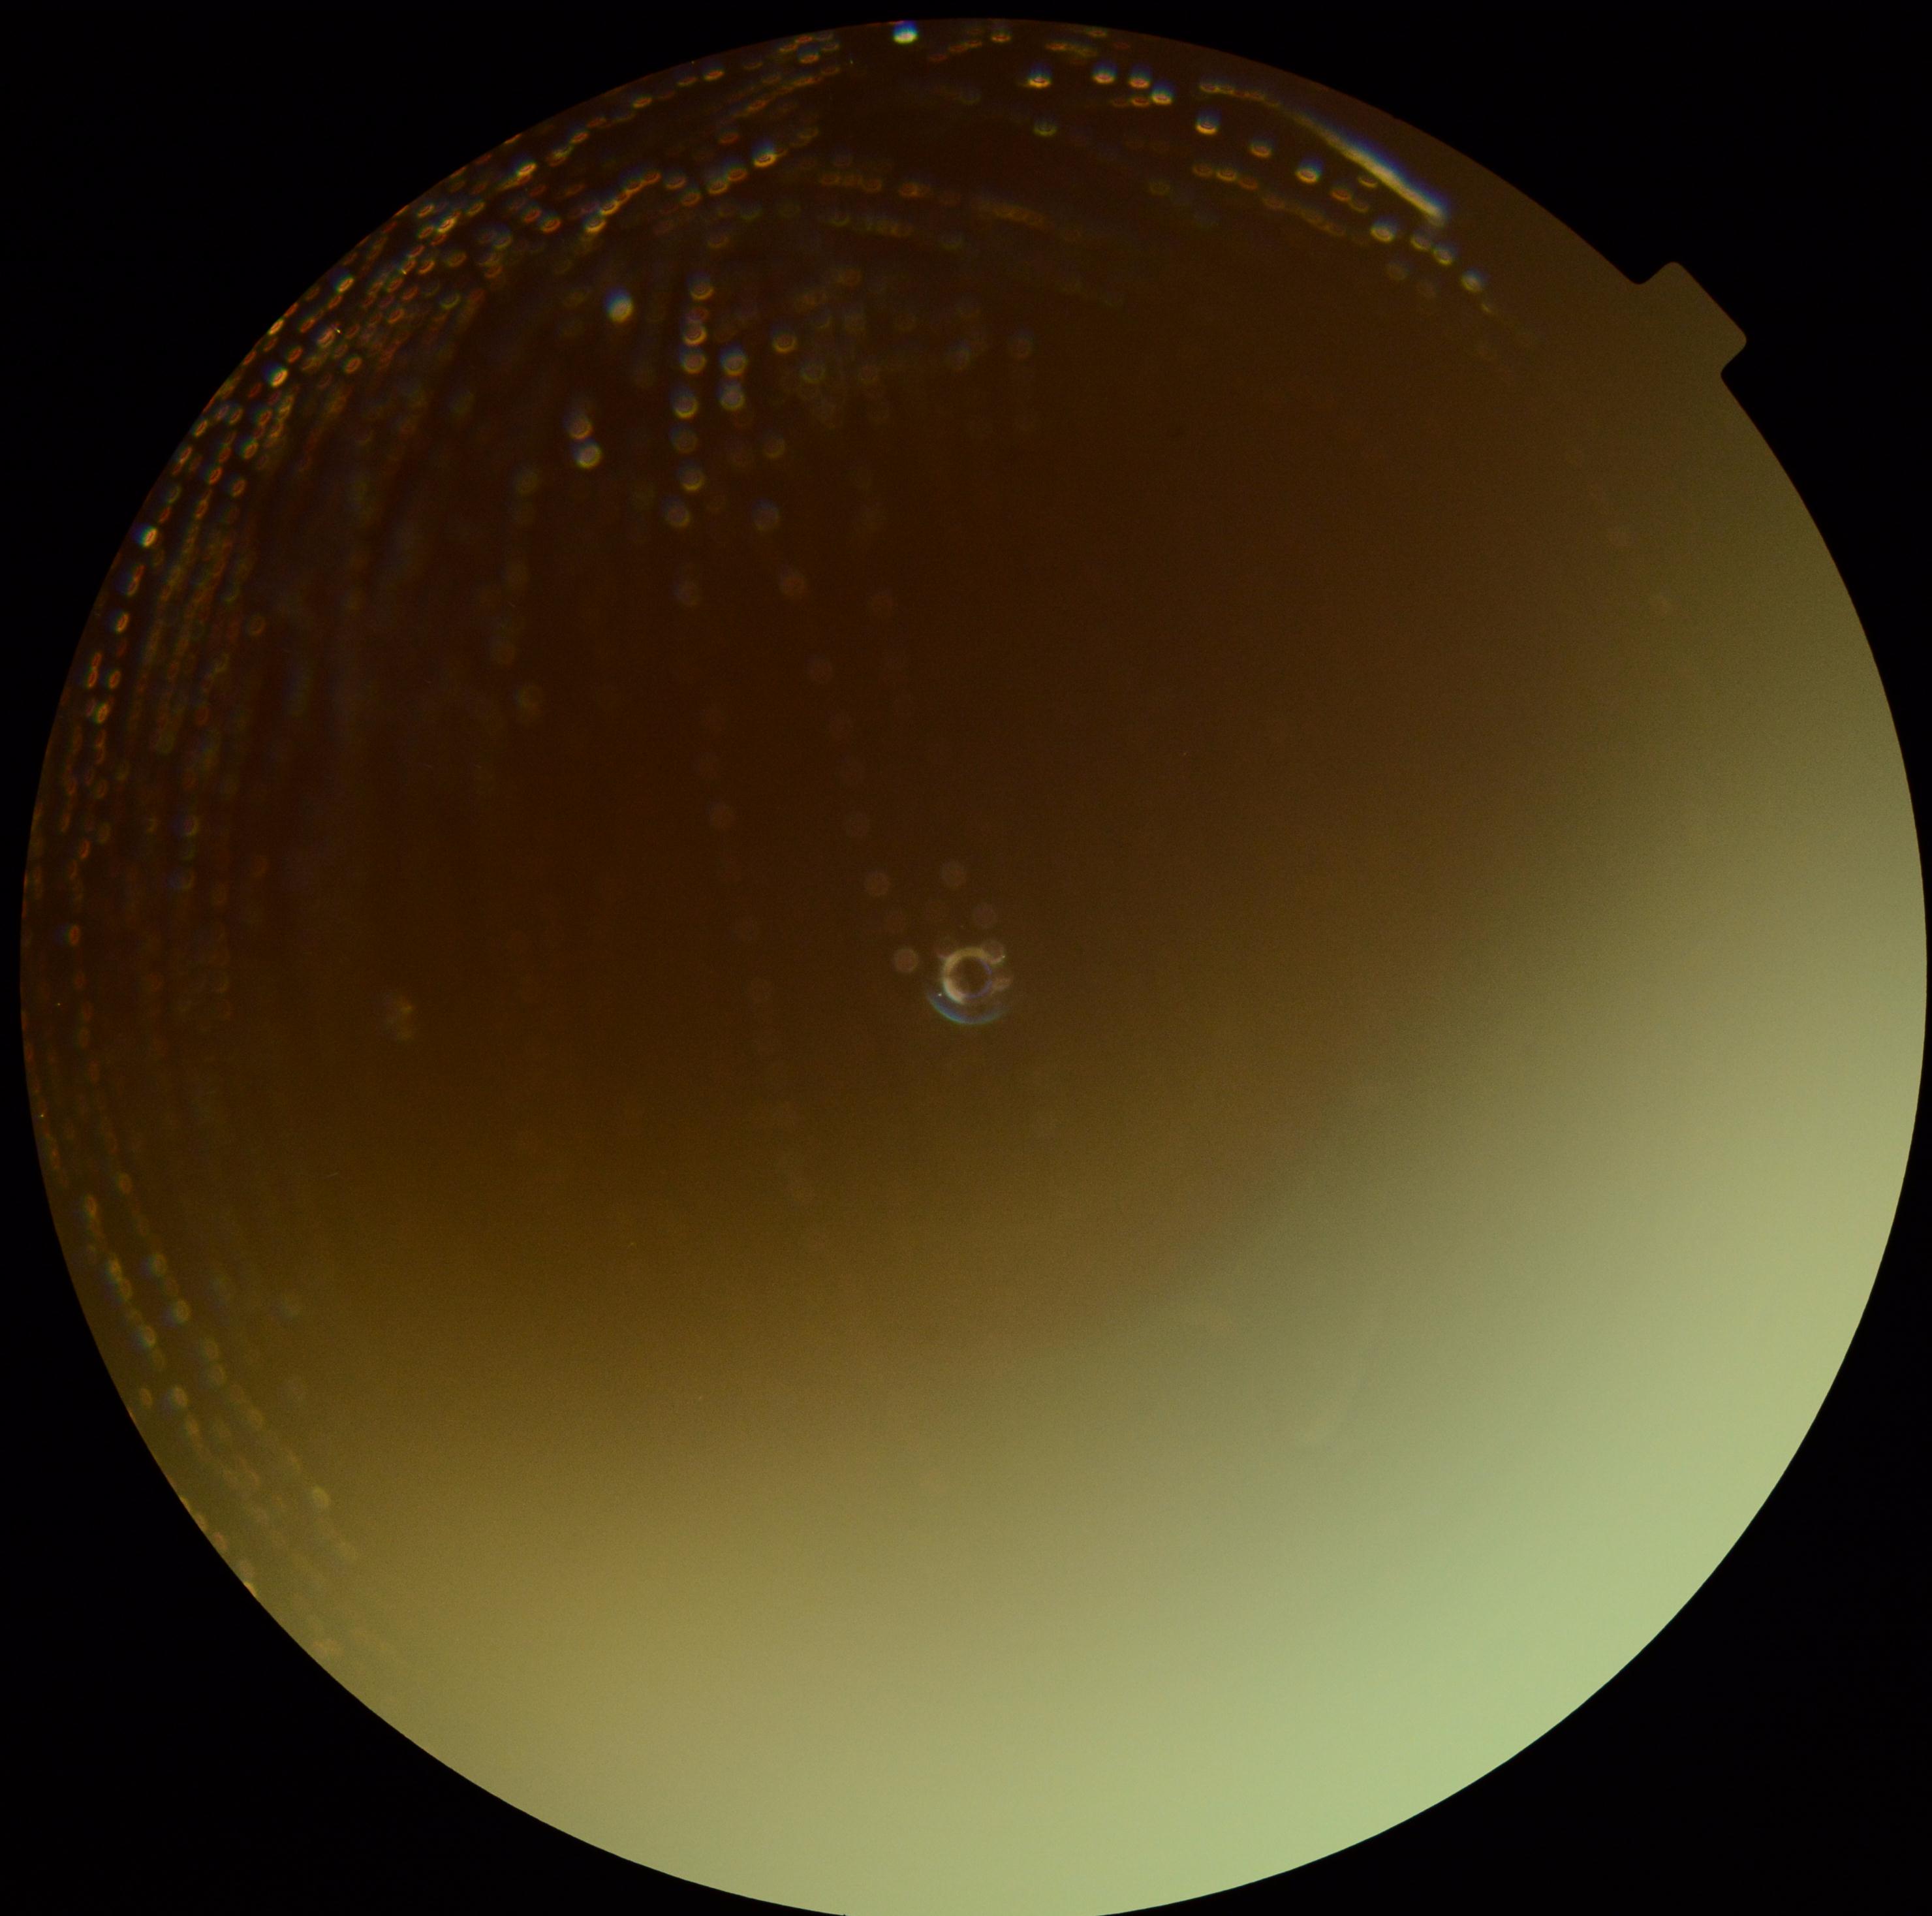
diabetic retinopathy (DR): ungradable due to poor image quality.